Graded on the modified Davis scale — 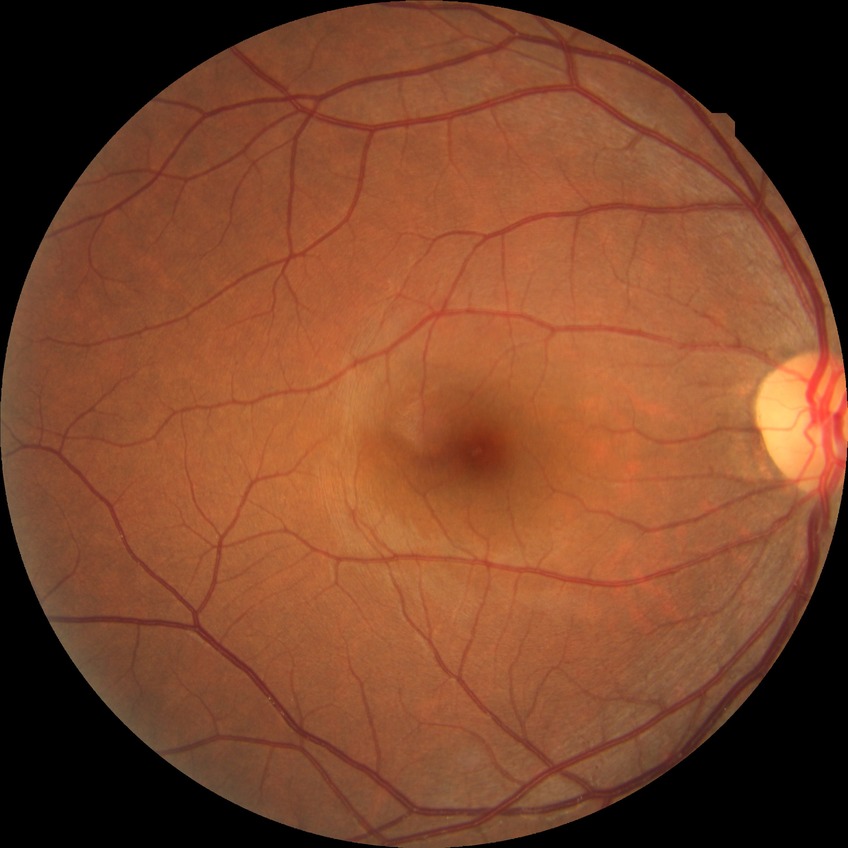
Diabetic retinopathy (DR): no diabetic retinopathy (NDR).